2352x1568px; fundus photo.
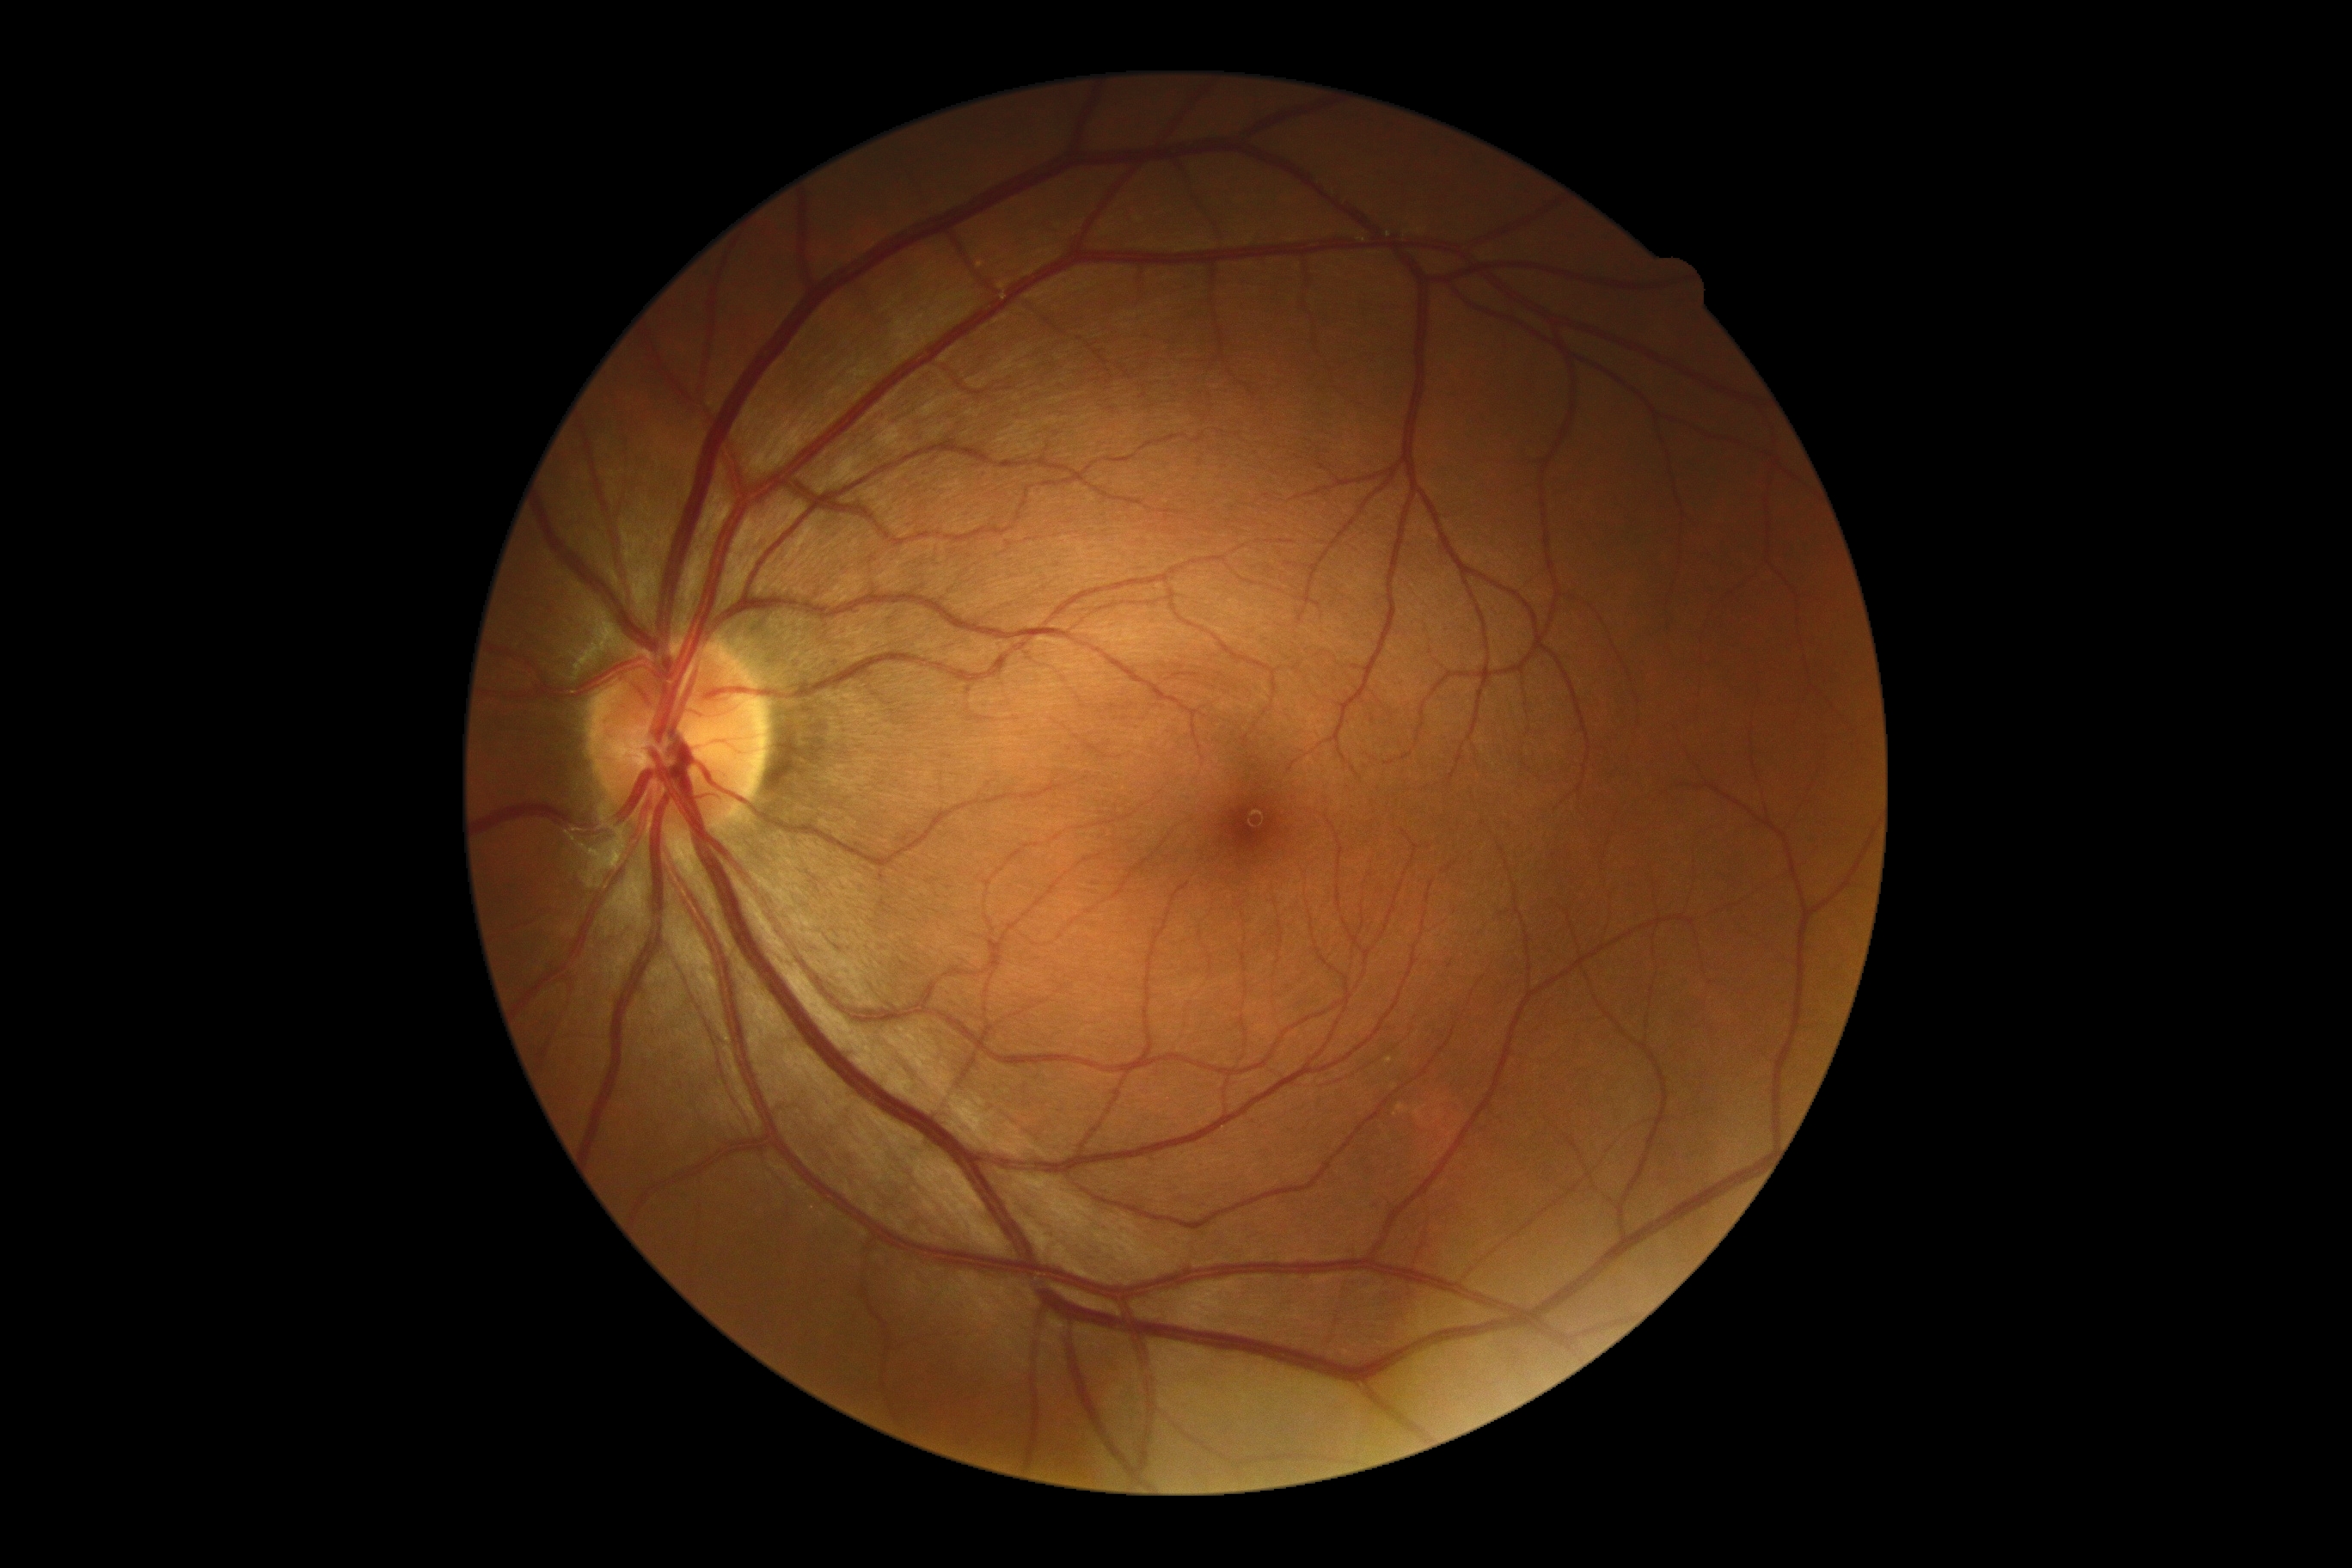 diabetic retinopathy (DR): no apparent diabetic retinopathy (grade 0).